Fundus photo, 45° FOV, image size 1932x1916
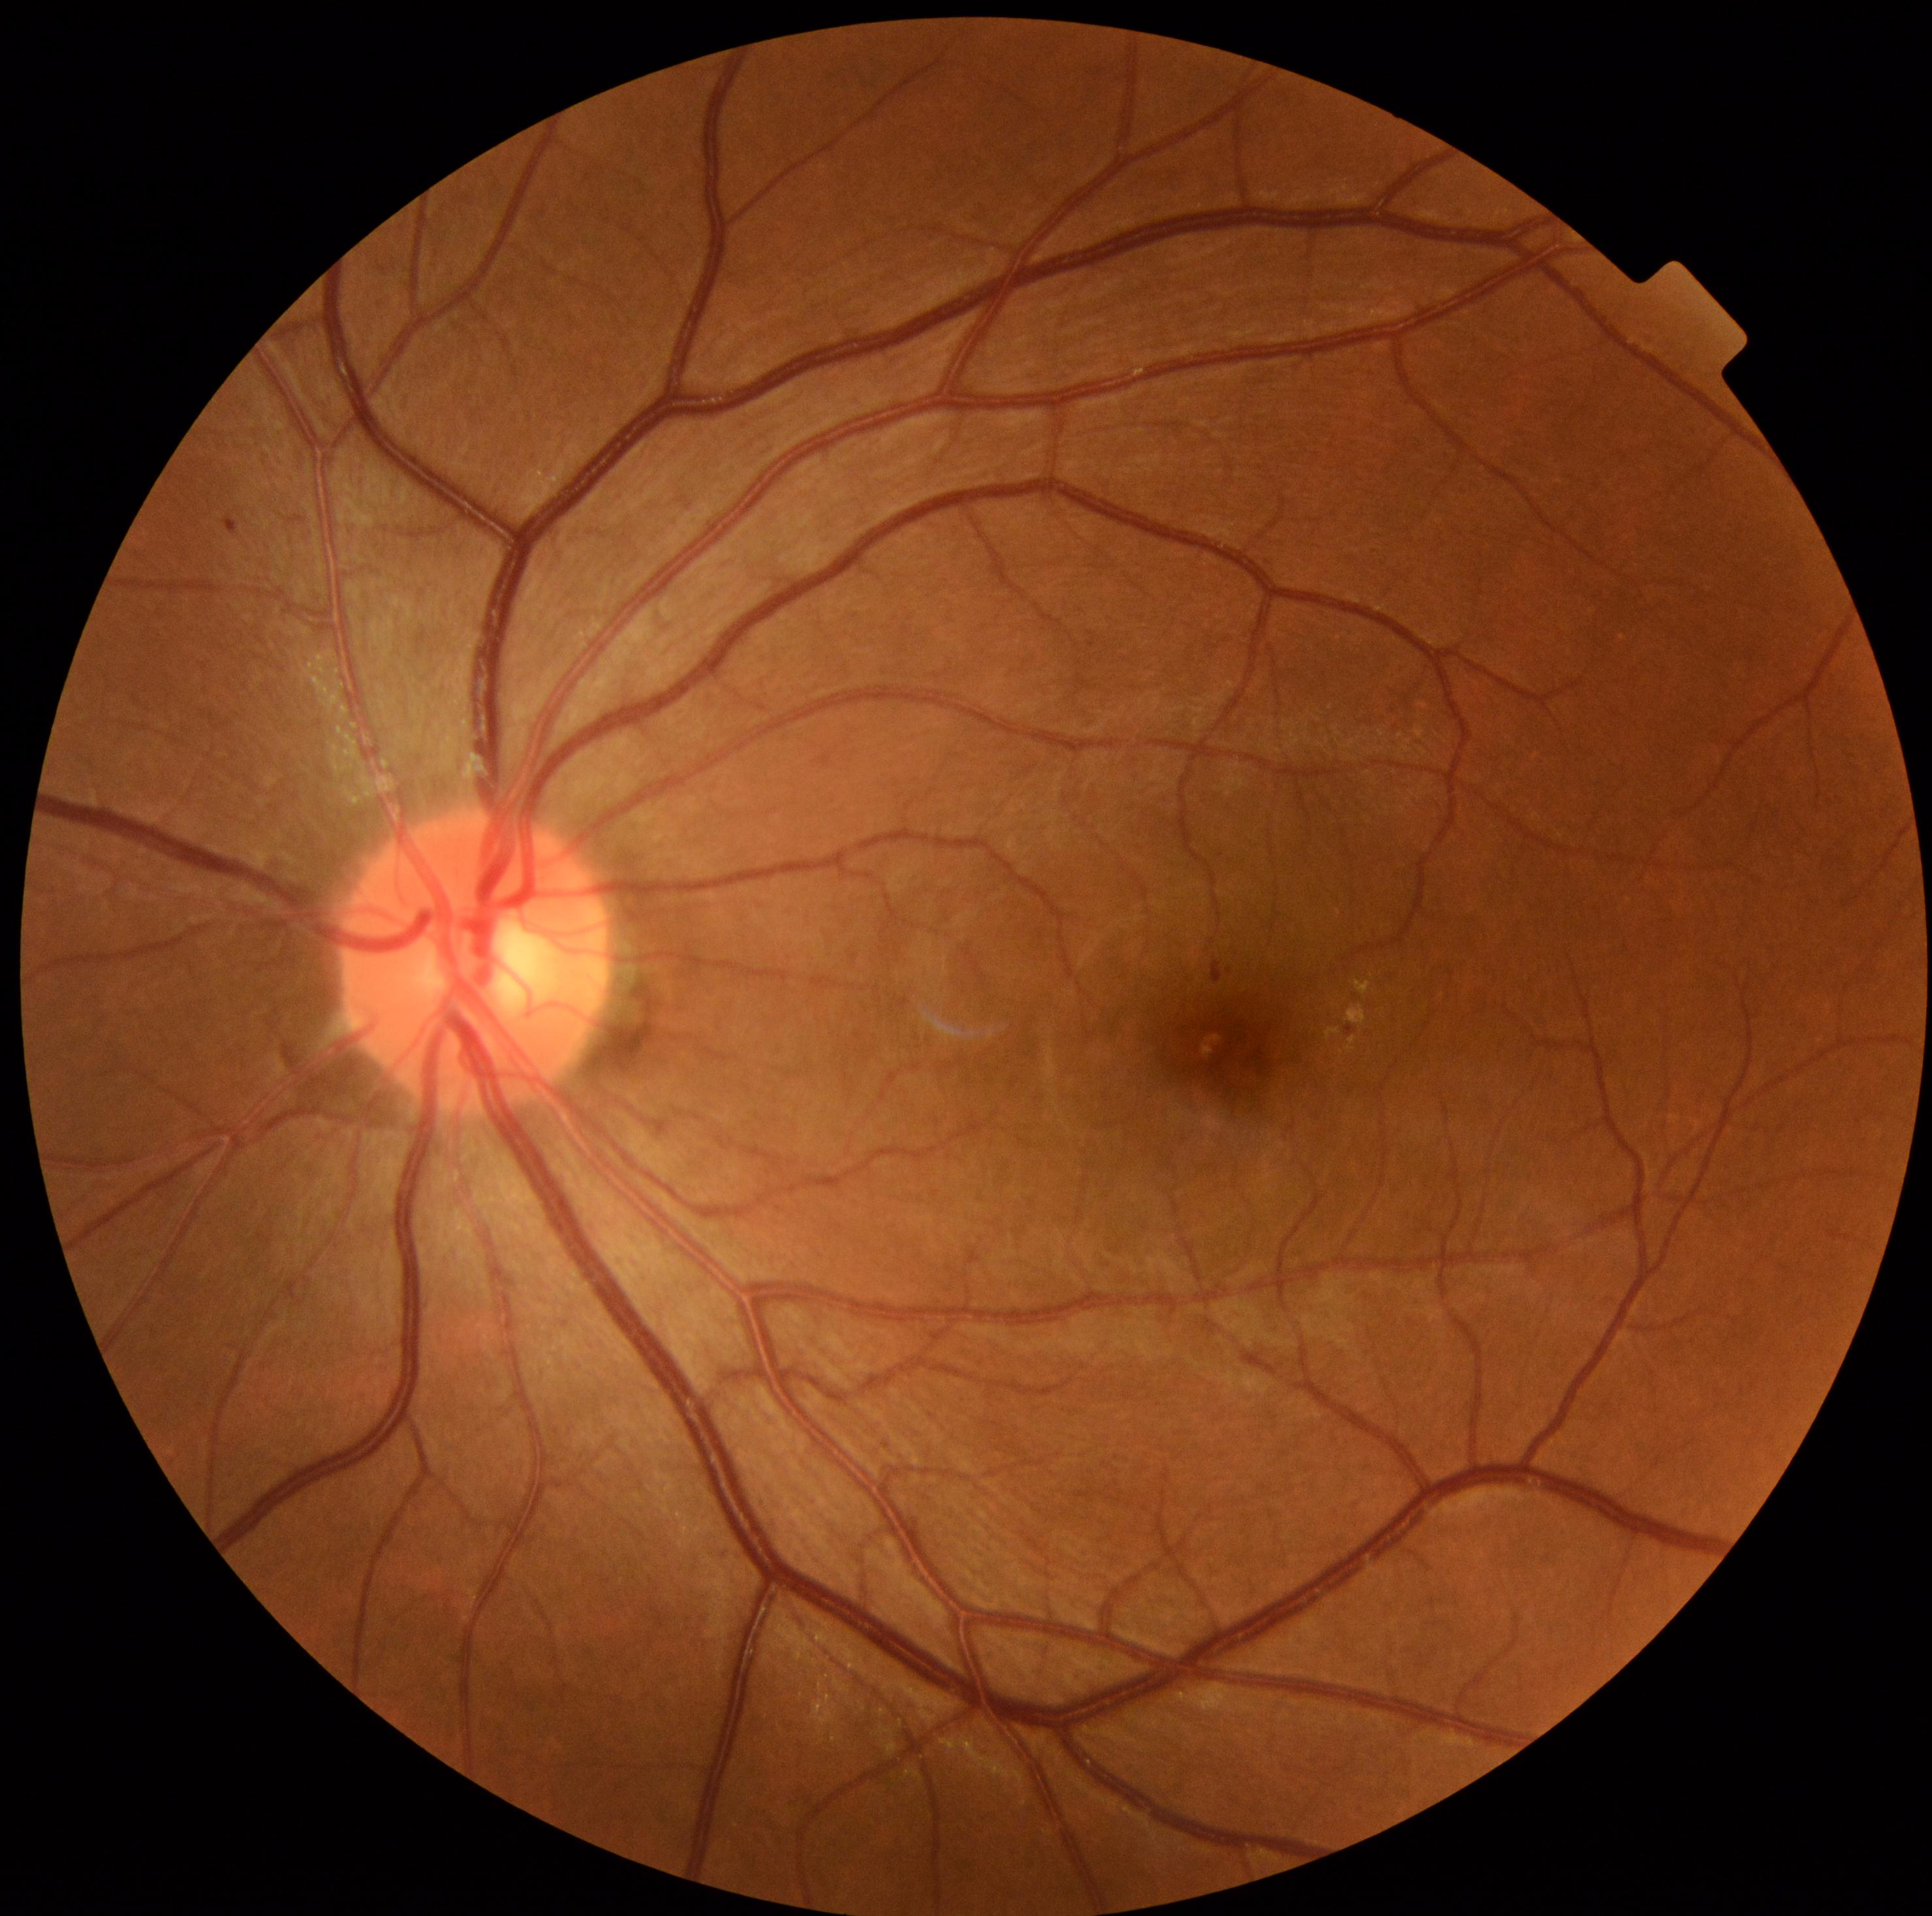

DR grade is 2/4.